2212x1659px · 45-degree field of view · CFP — 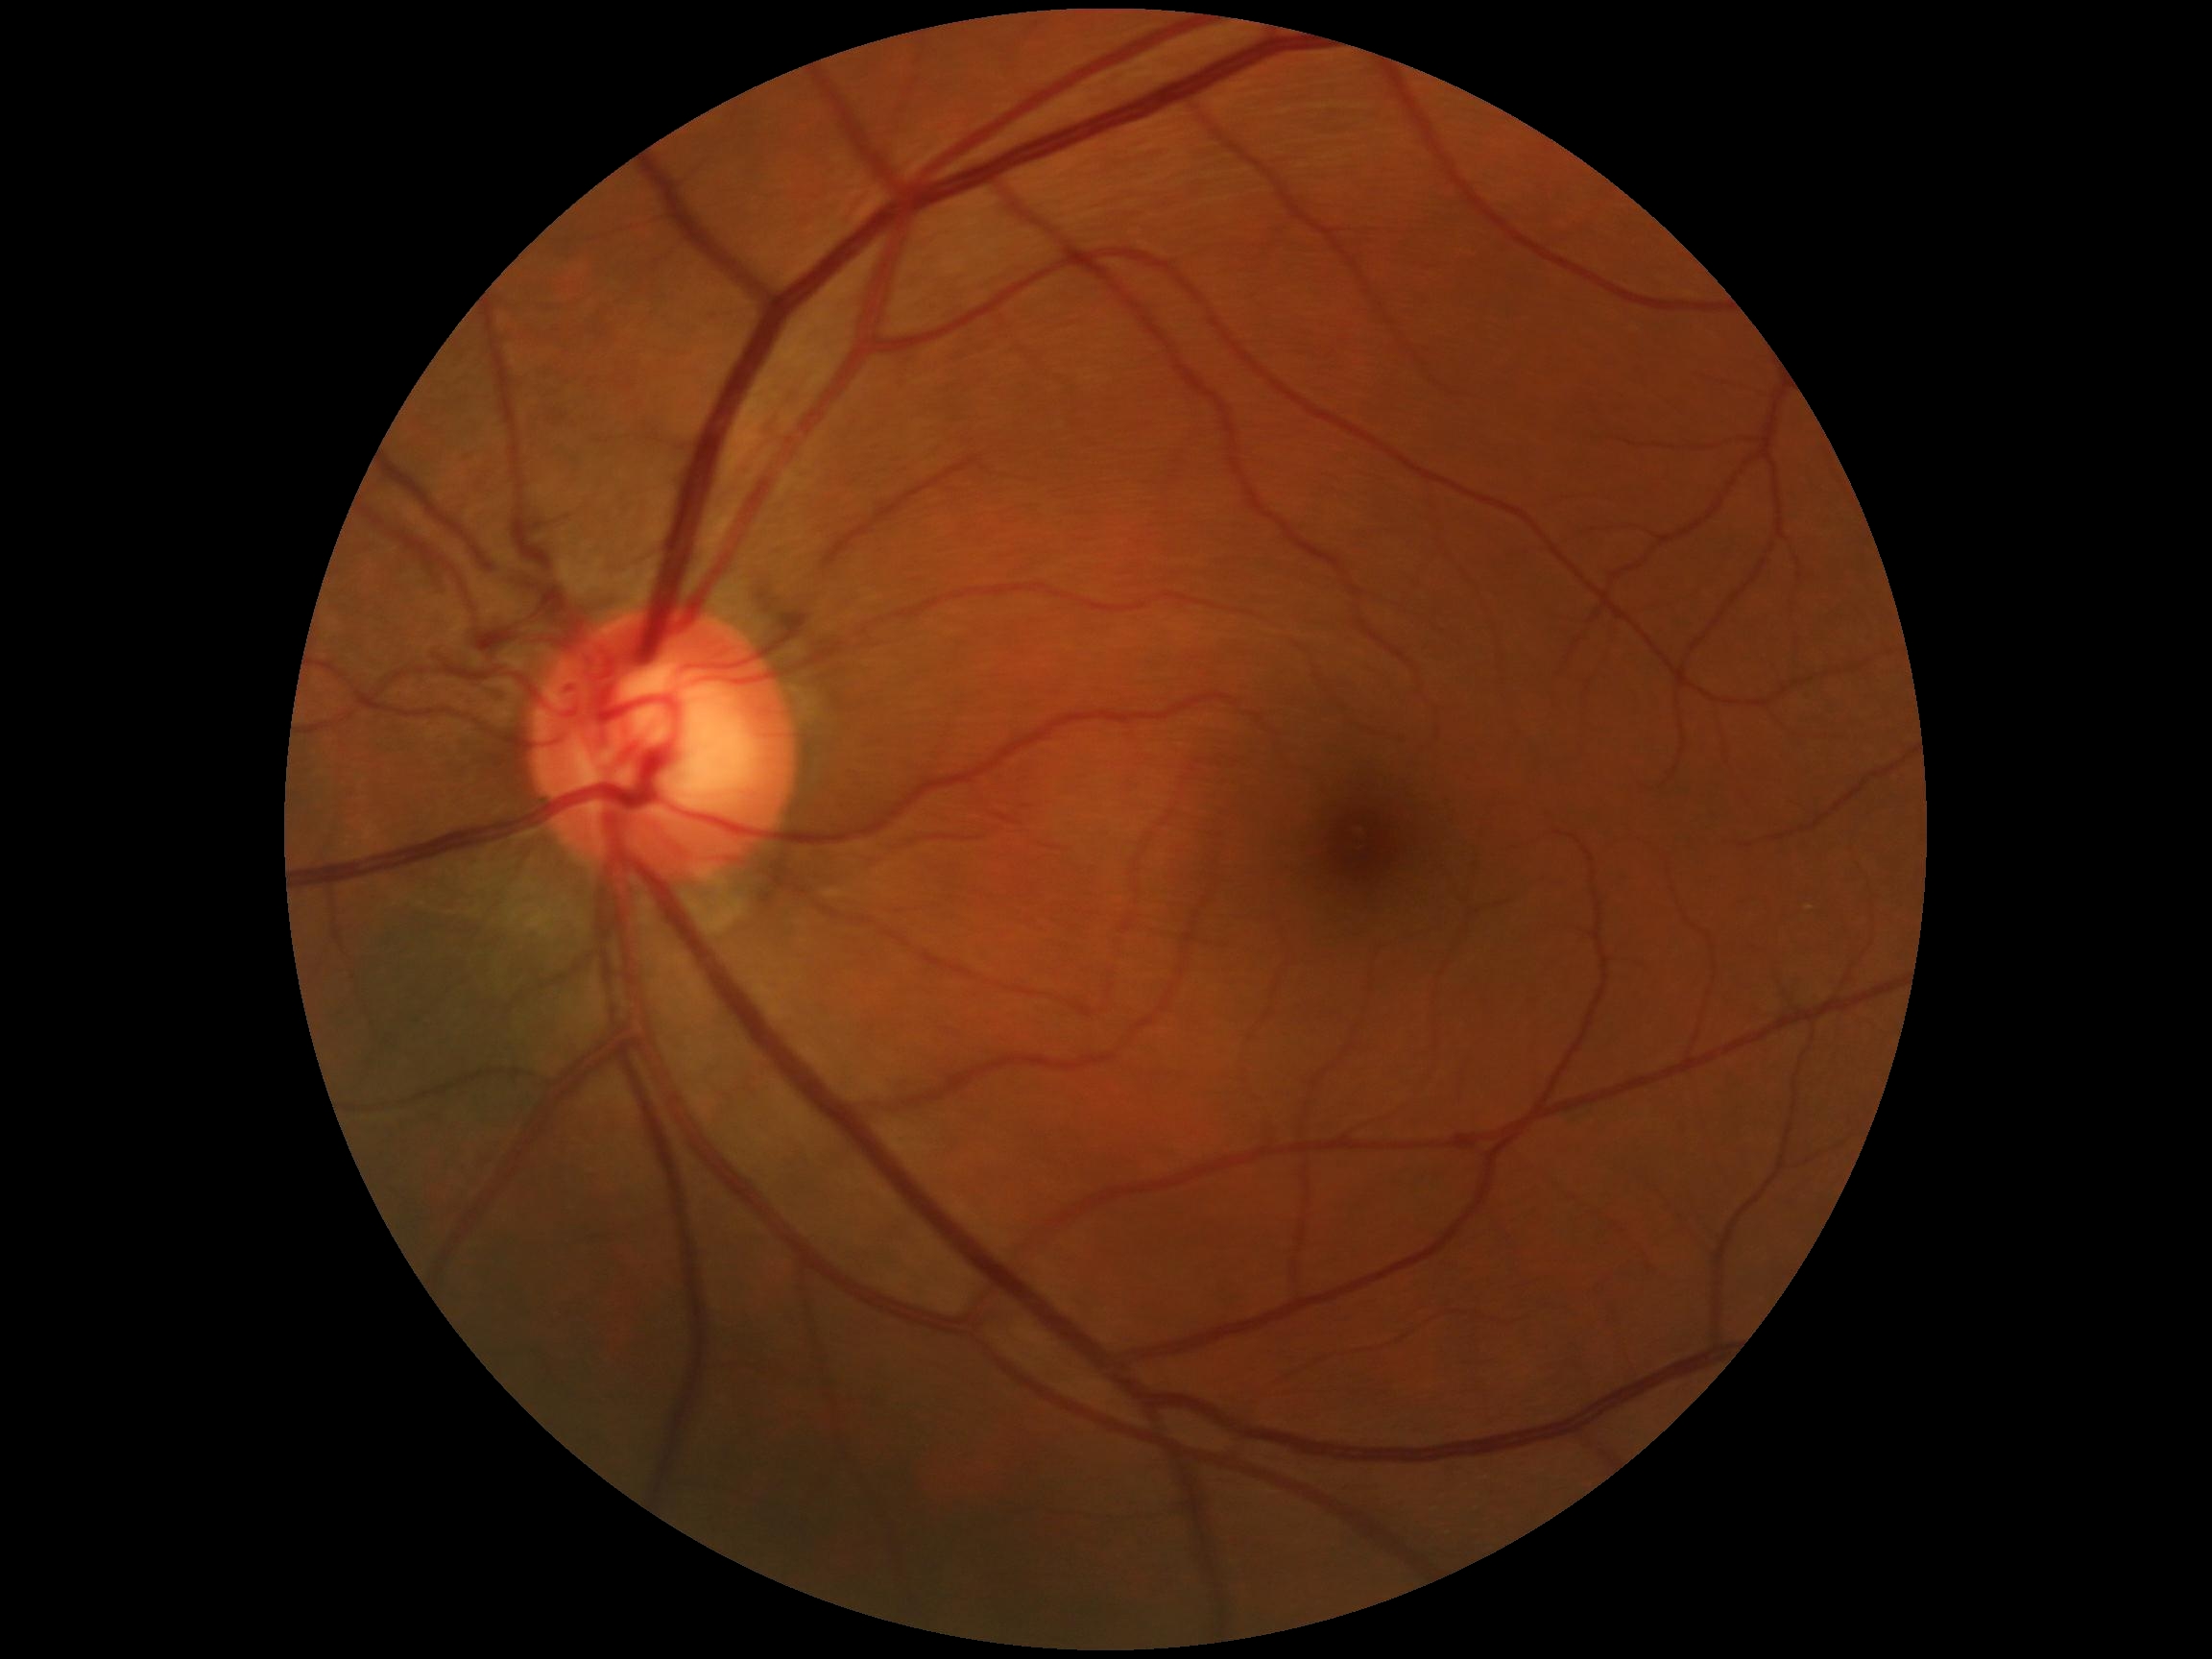
DR grade: 0.